2089x1764px:
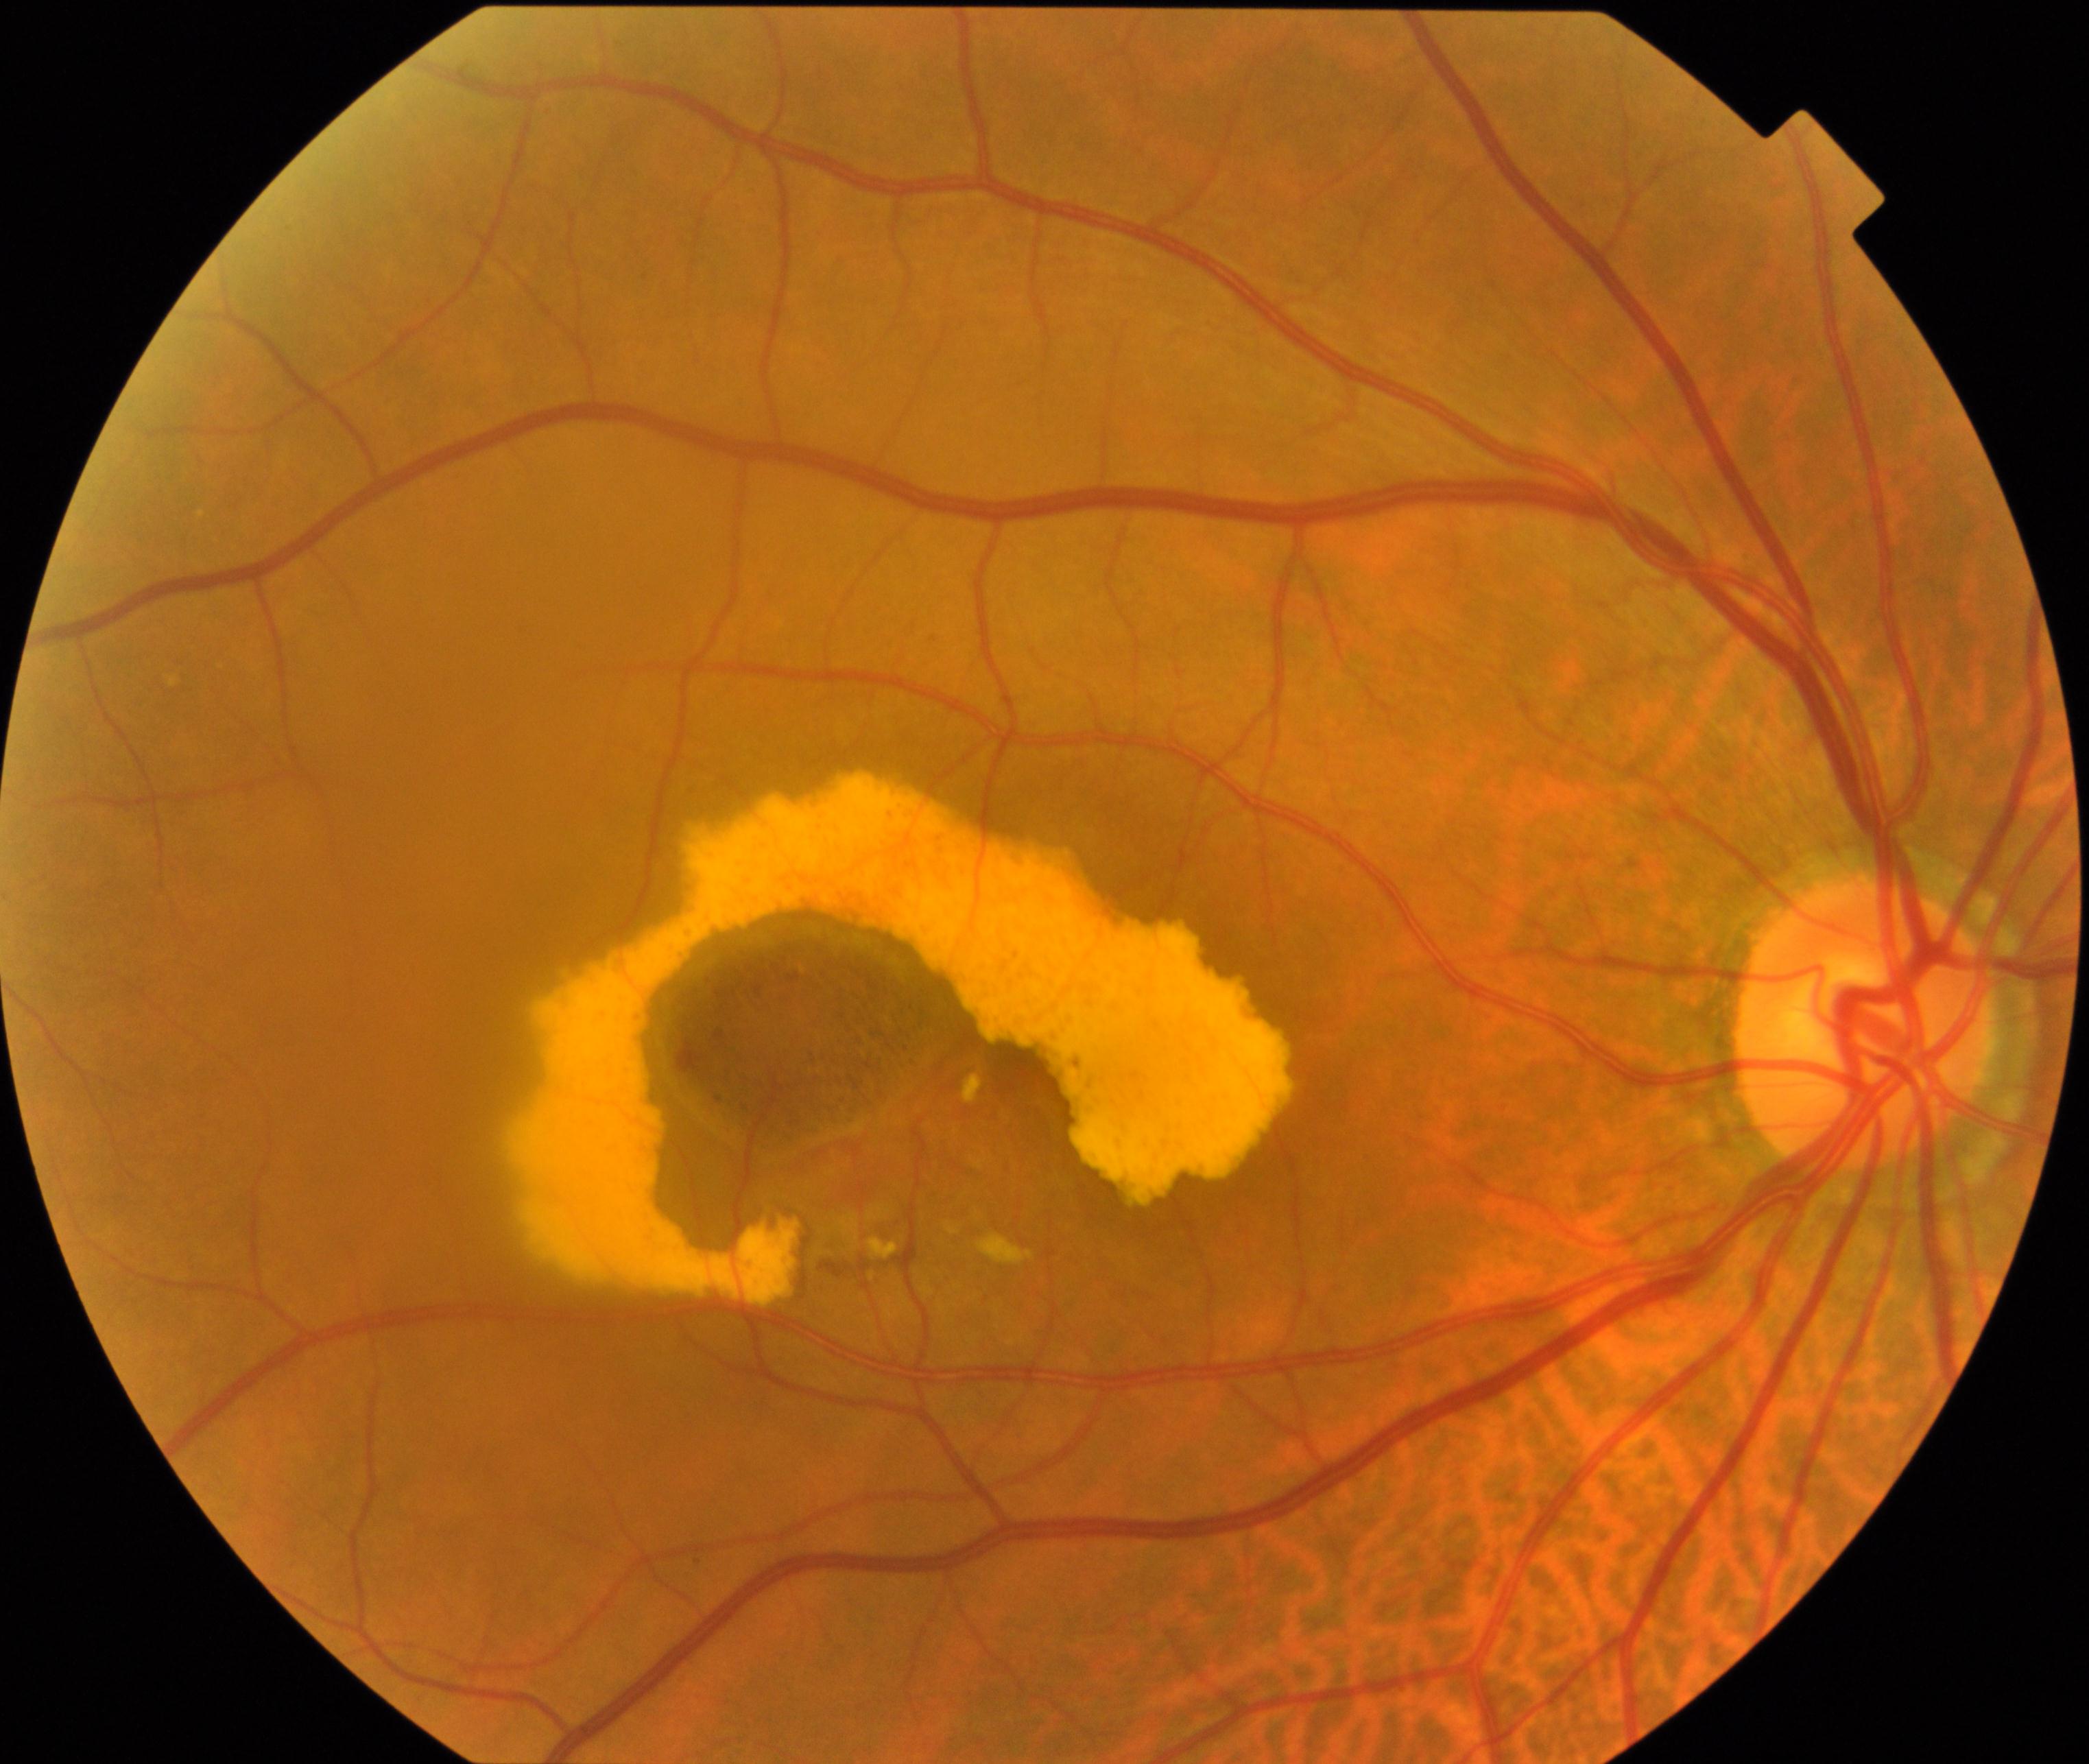 Fundus image consistent with maculopathy.